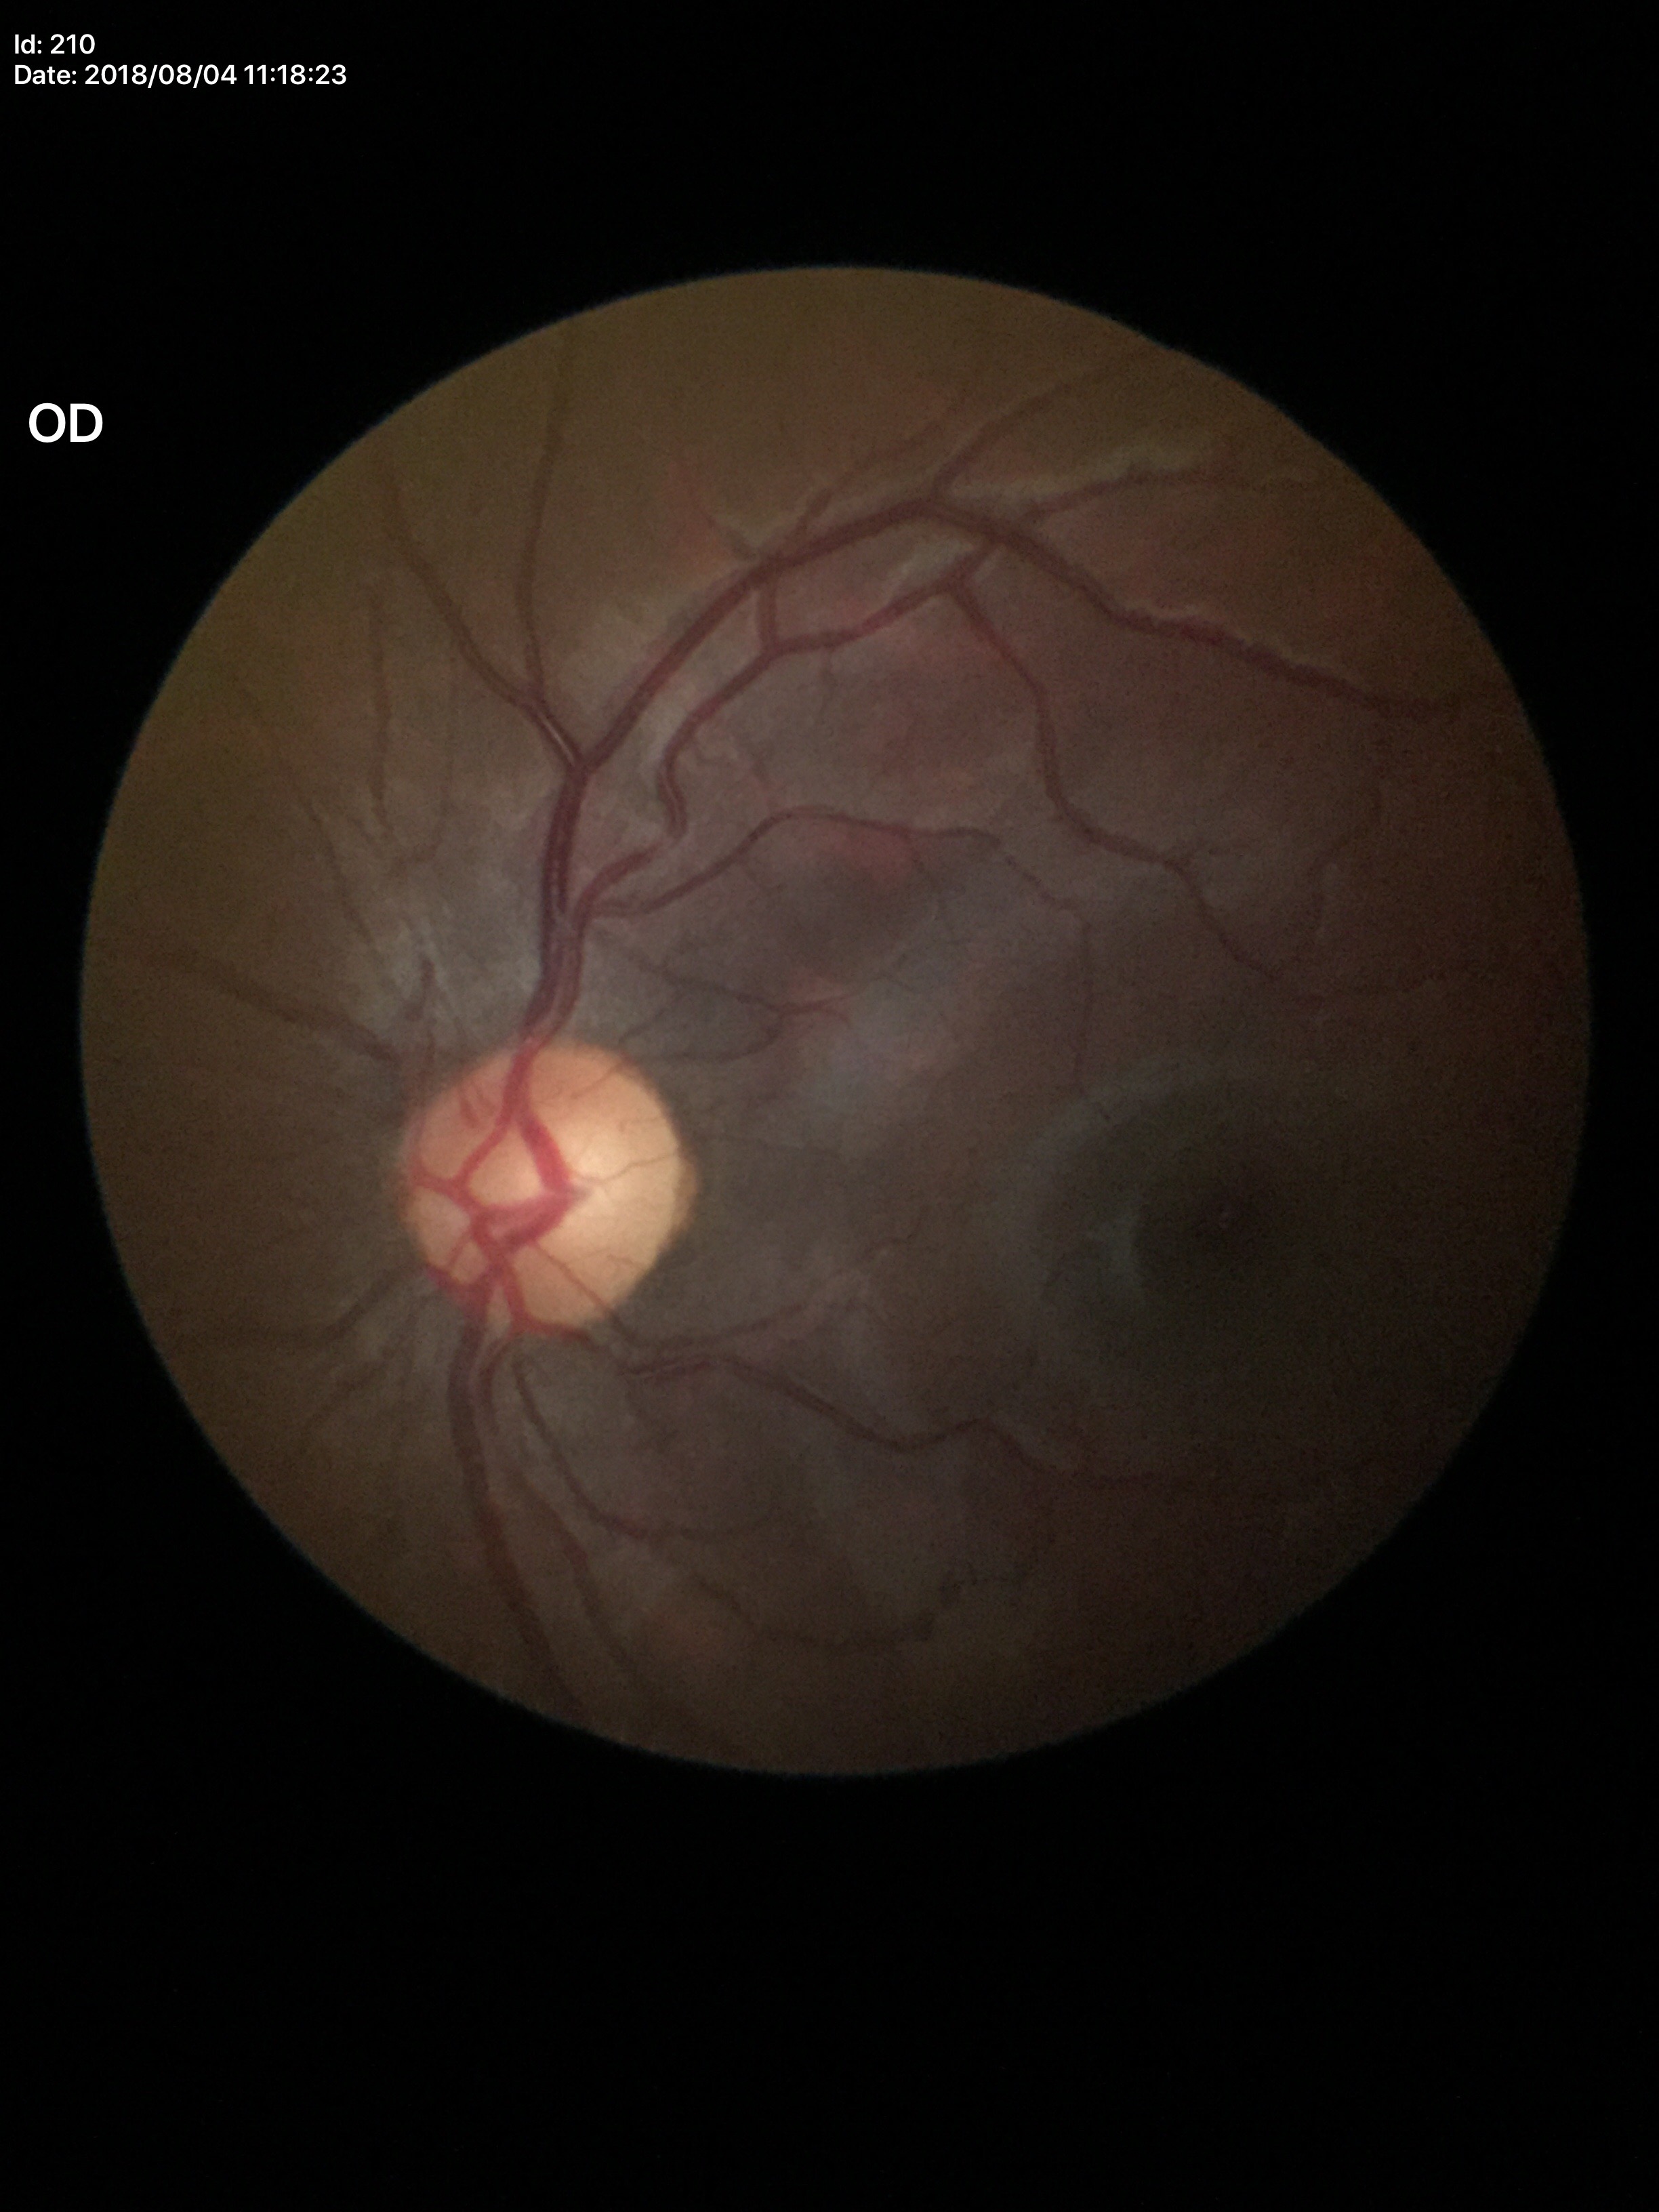 Vertical CDR (VCDR) of 0.57. Glaucoma screening impression: negative (all 5 graders called normal). Area cup-to-disc ratio (ACDR) of 0.36.